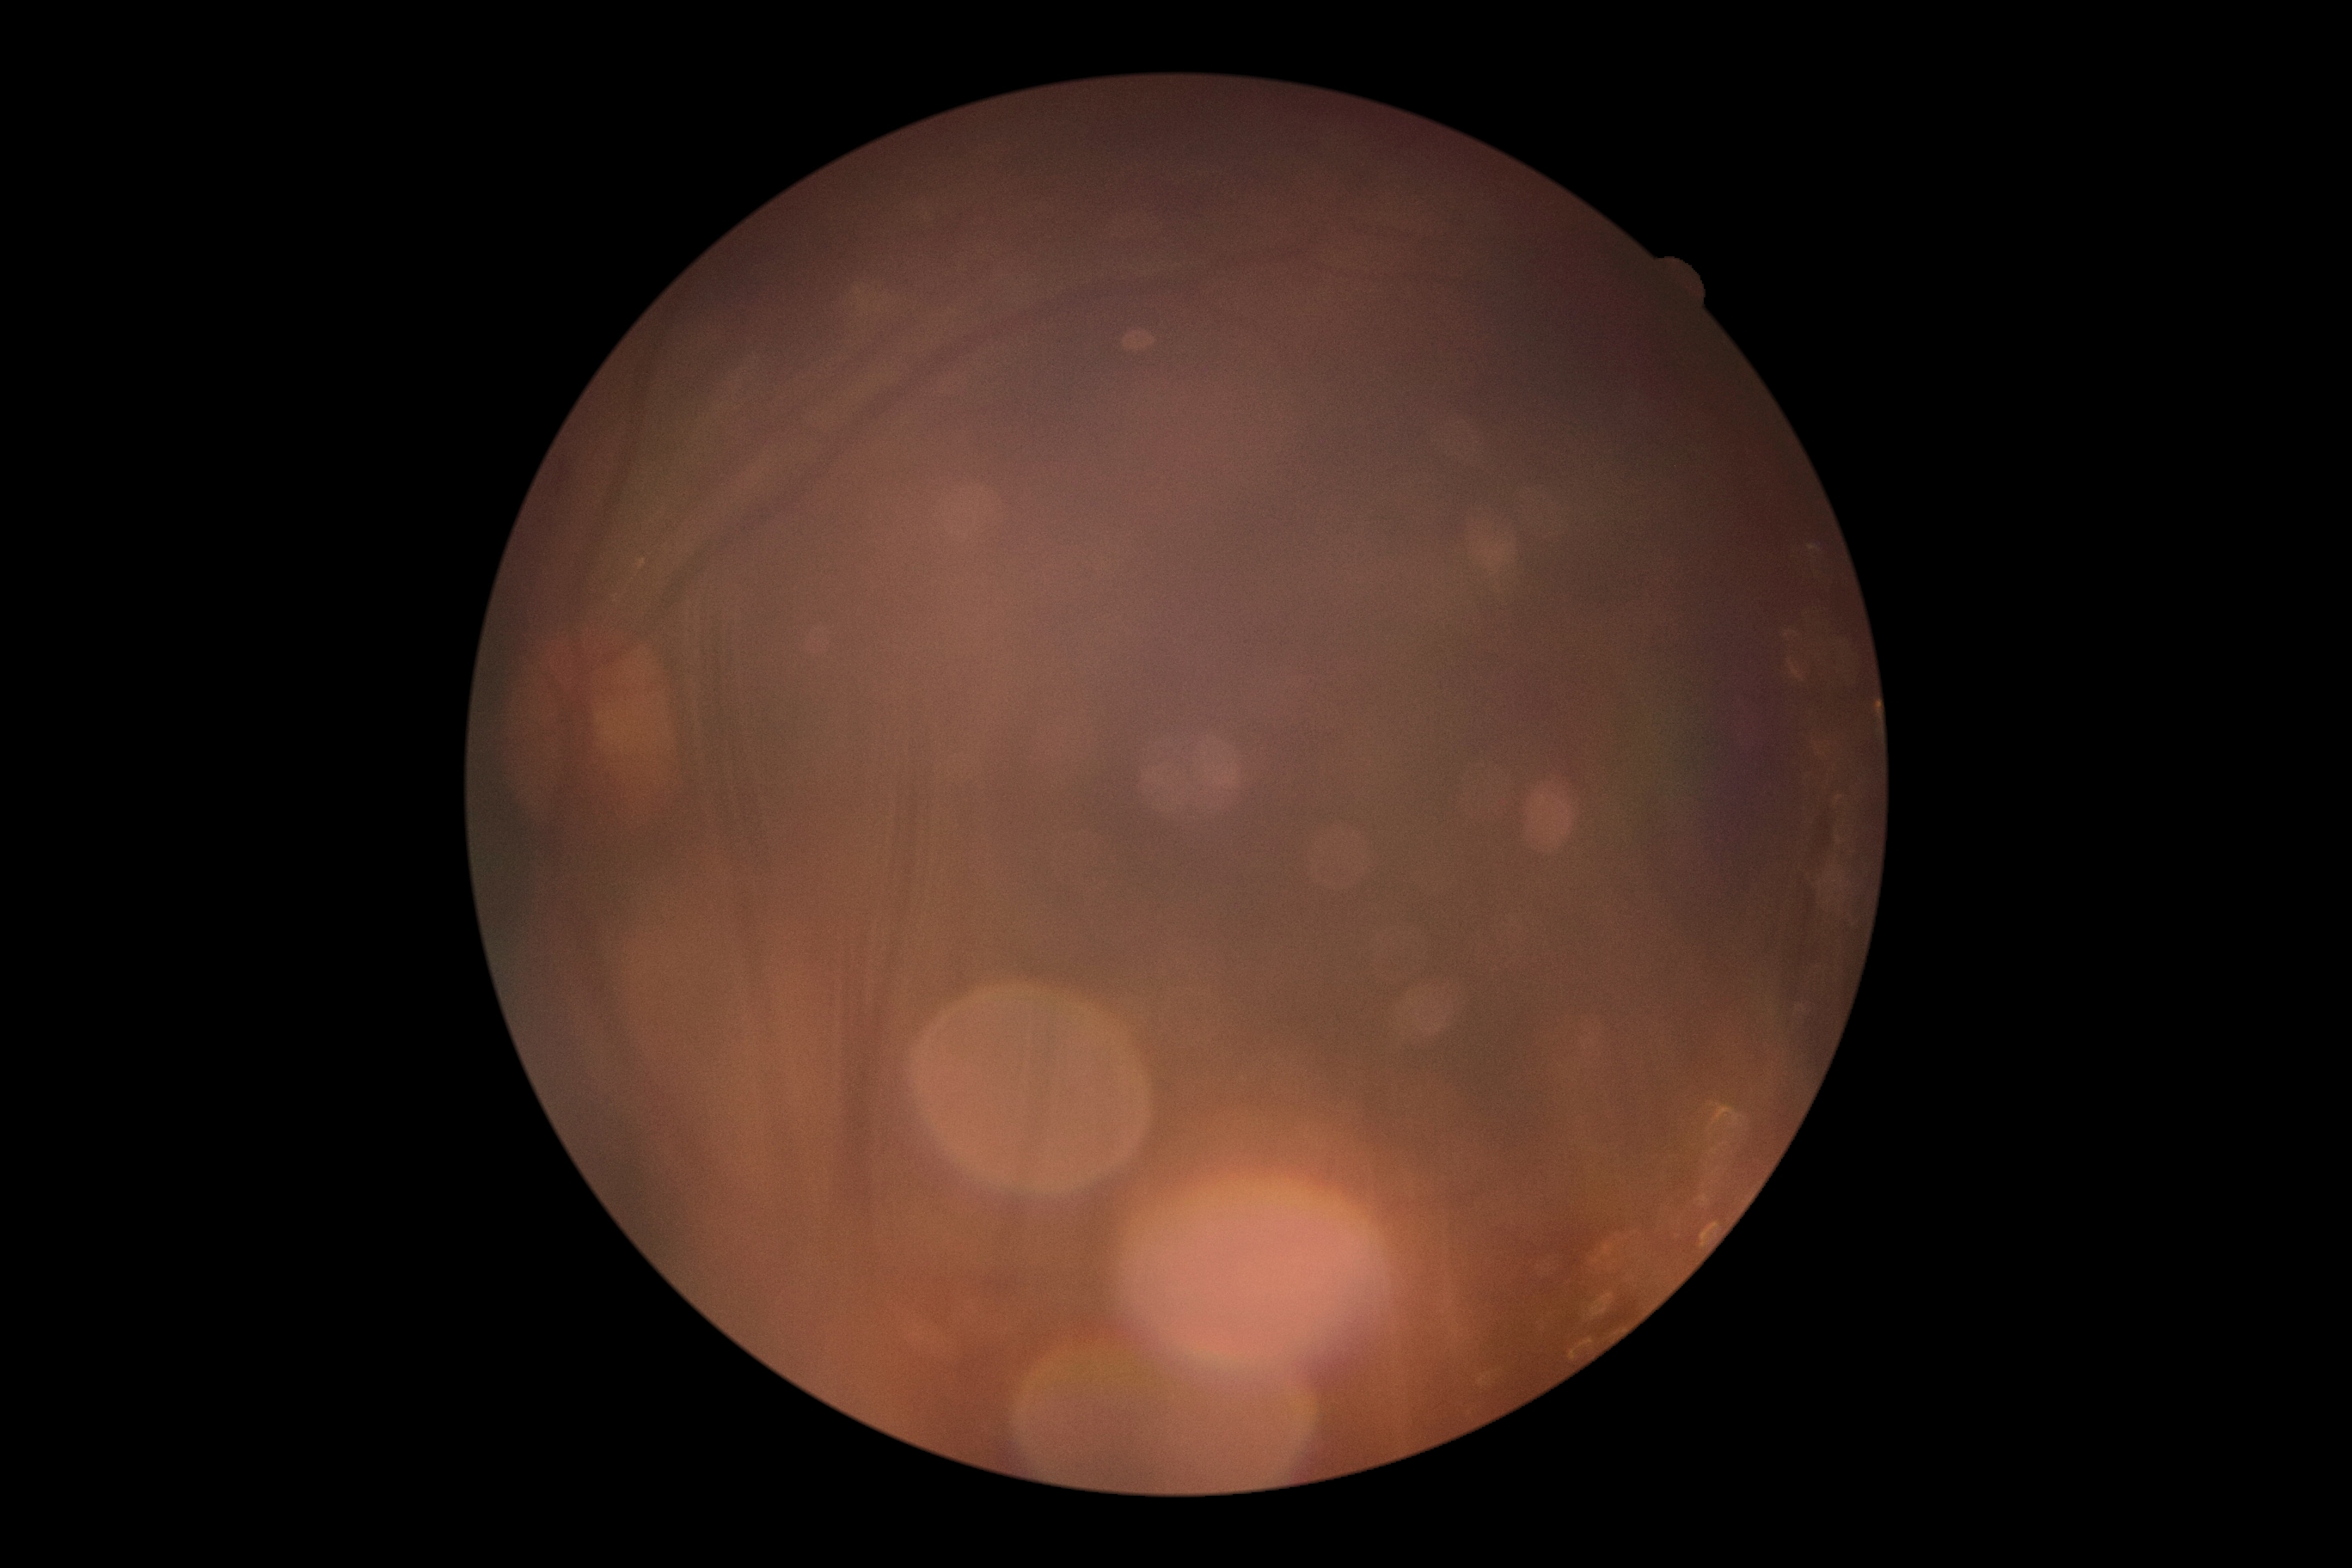

DR grade: ungradable.
Image quality is insufficient for diabetic retinopathy assessment.